60° FOV. Portable fundus camera image
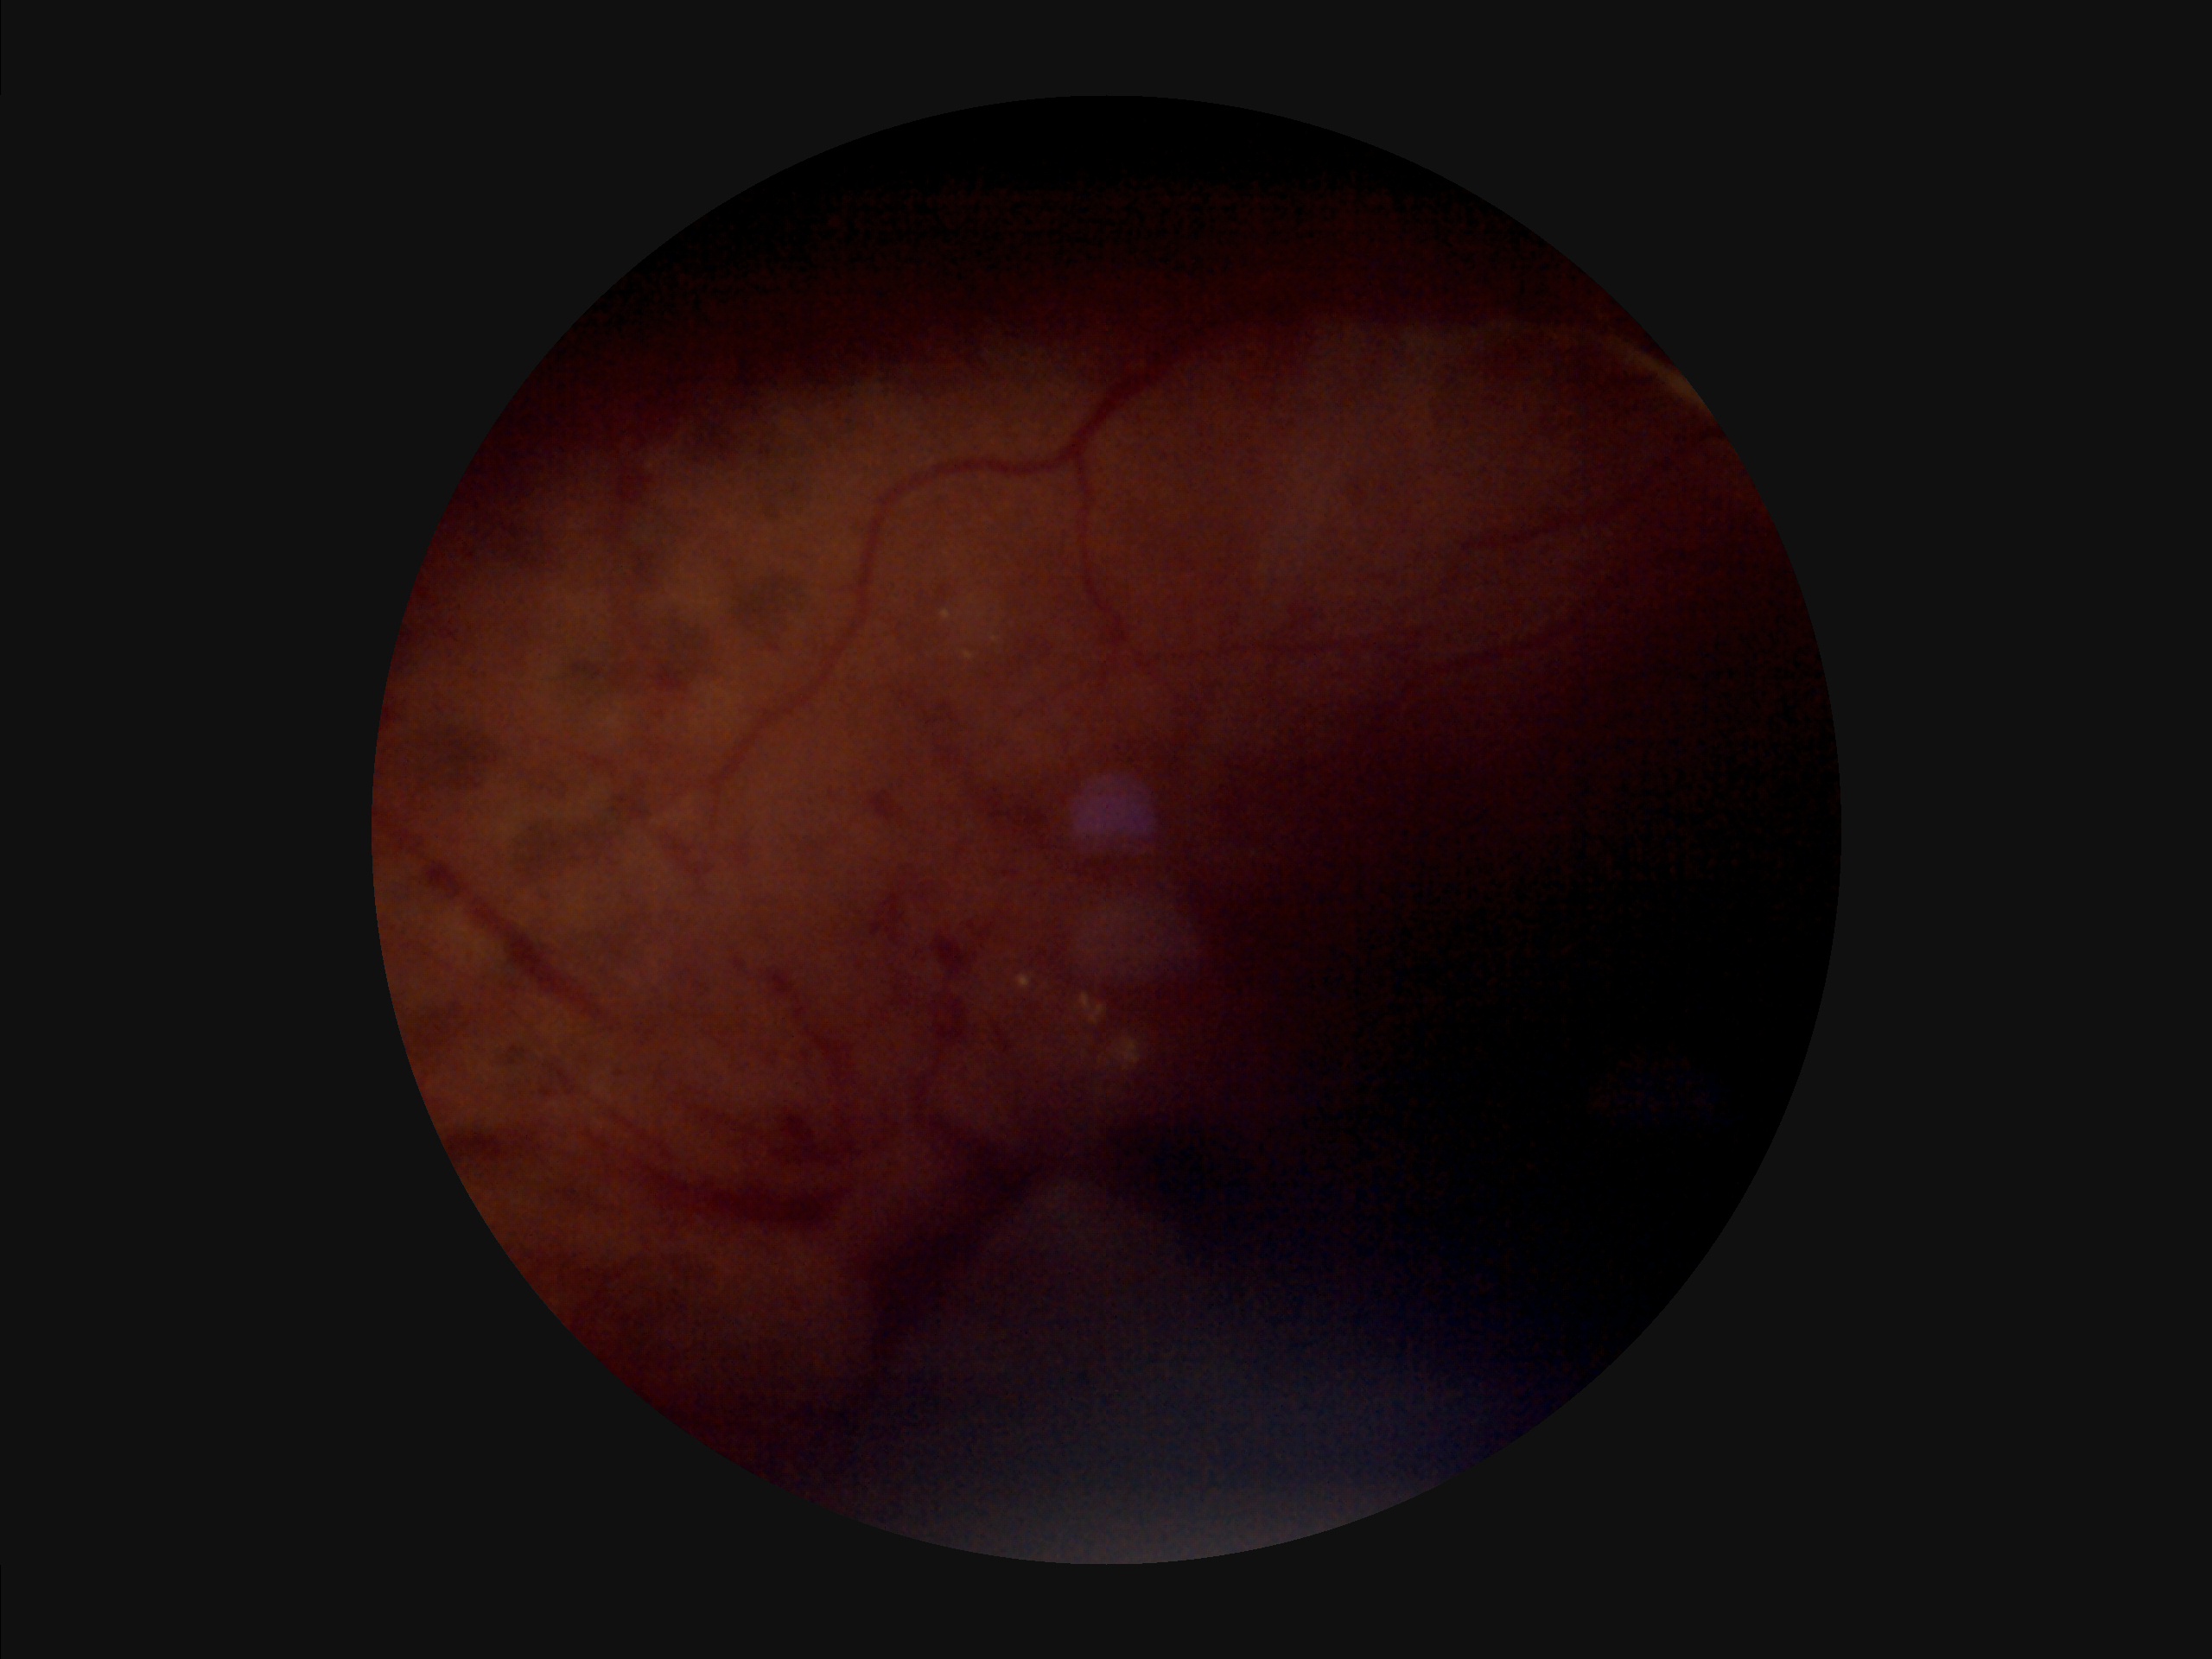   overall_quality: suboptimal
  clarity: poor
  contrast: poor
  illumination: poor